Image size 2228x1652. Posterior pole field covering the optic disc and macula
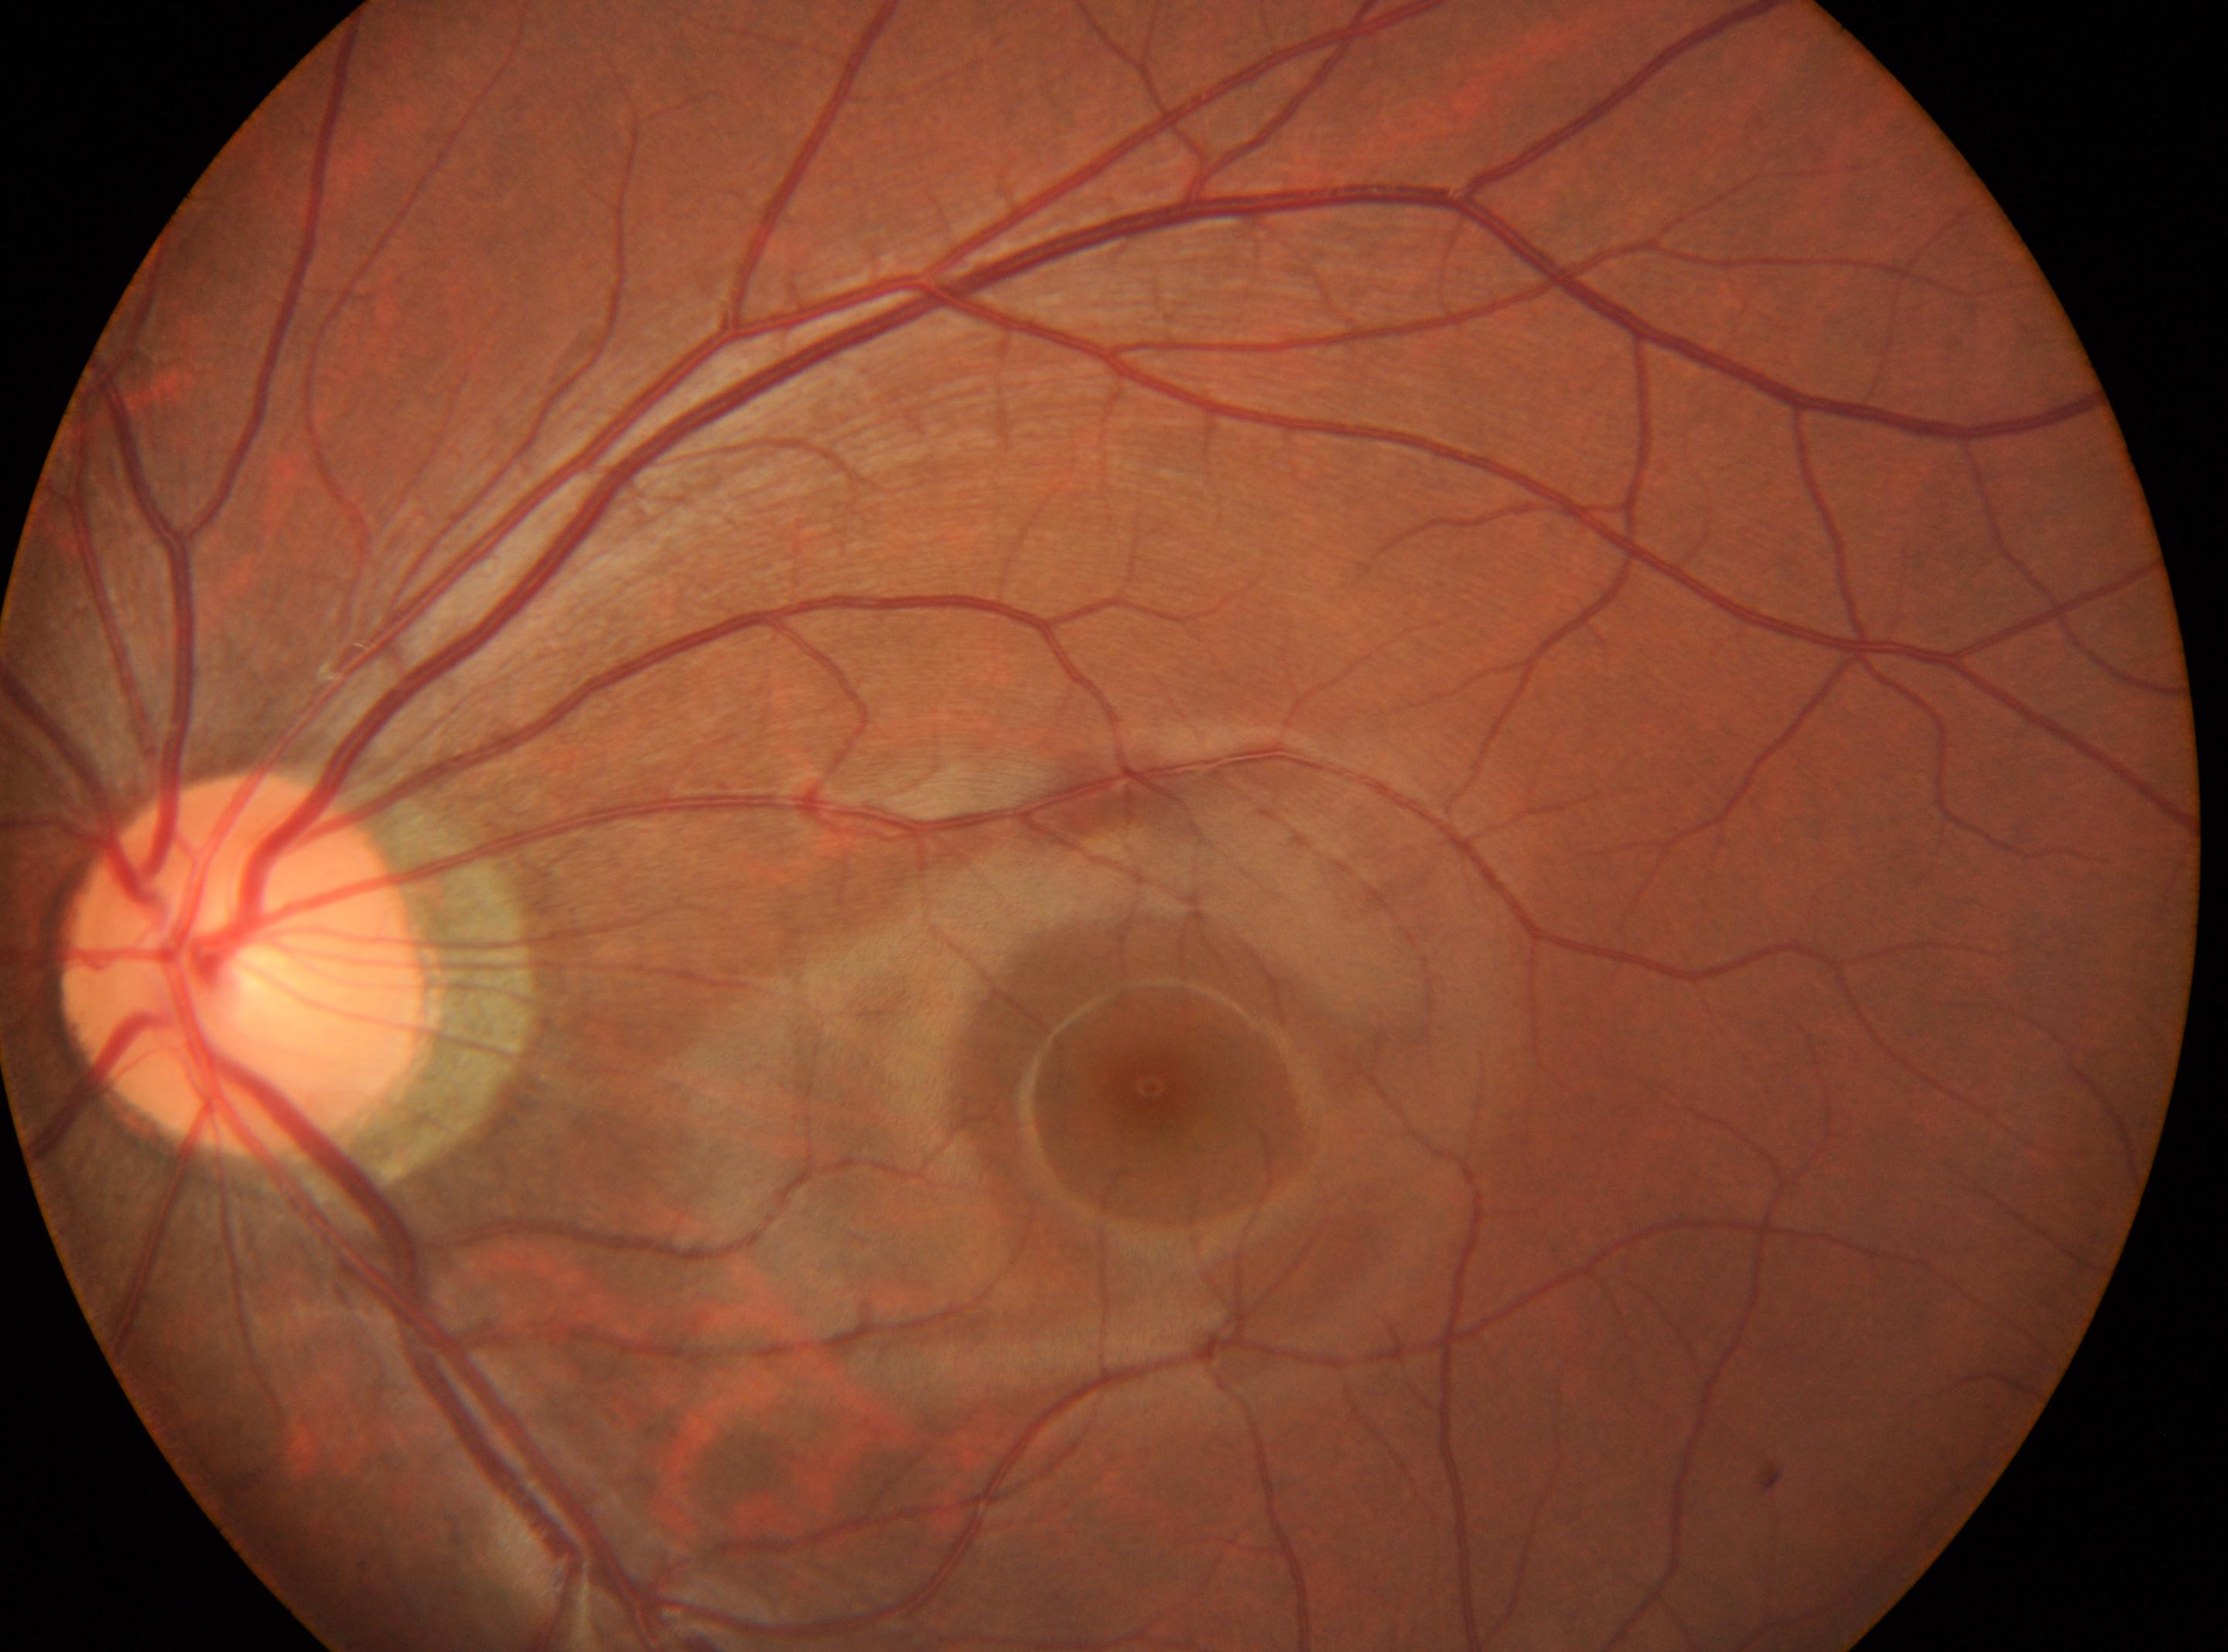

| field | value |
|---|---|
| diabetic retinopathy (DR) | 0 — no visible signs of diabetic retinopathy |
| the optic disc | (246, 965) |
| laterality | the left eye |
| macular center | (1150, 1086) |